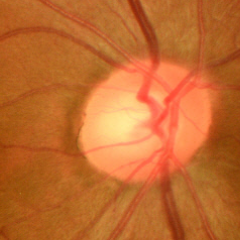

Glaucomatous changes are present. Diagnosis = early glaucomatous optic neuropathy.